2048 by 1536 pixels. Retinal fundus photograph — 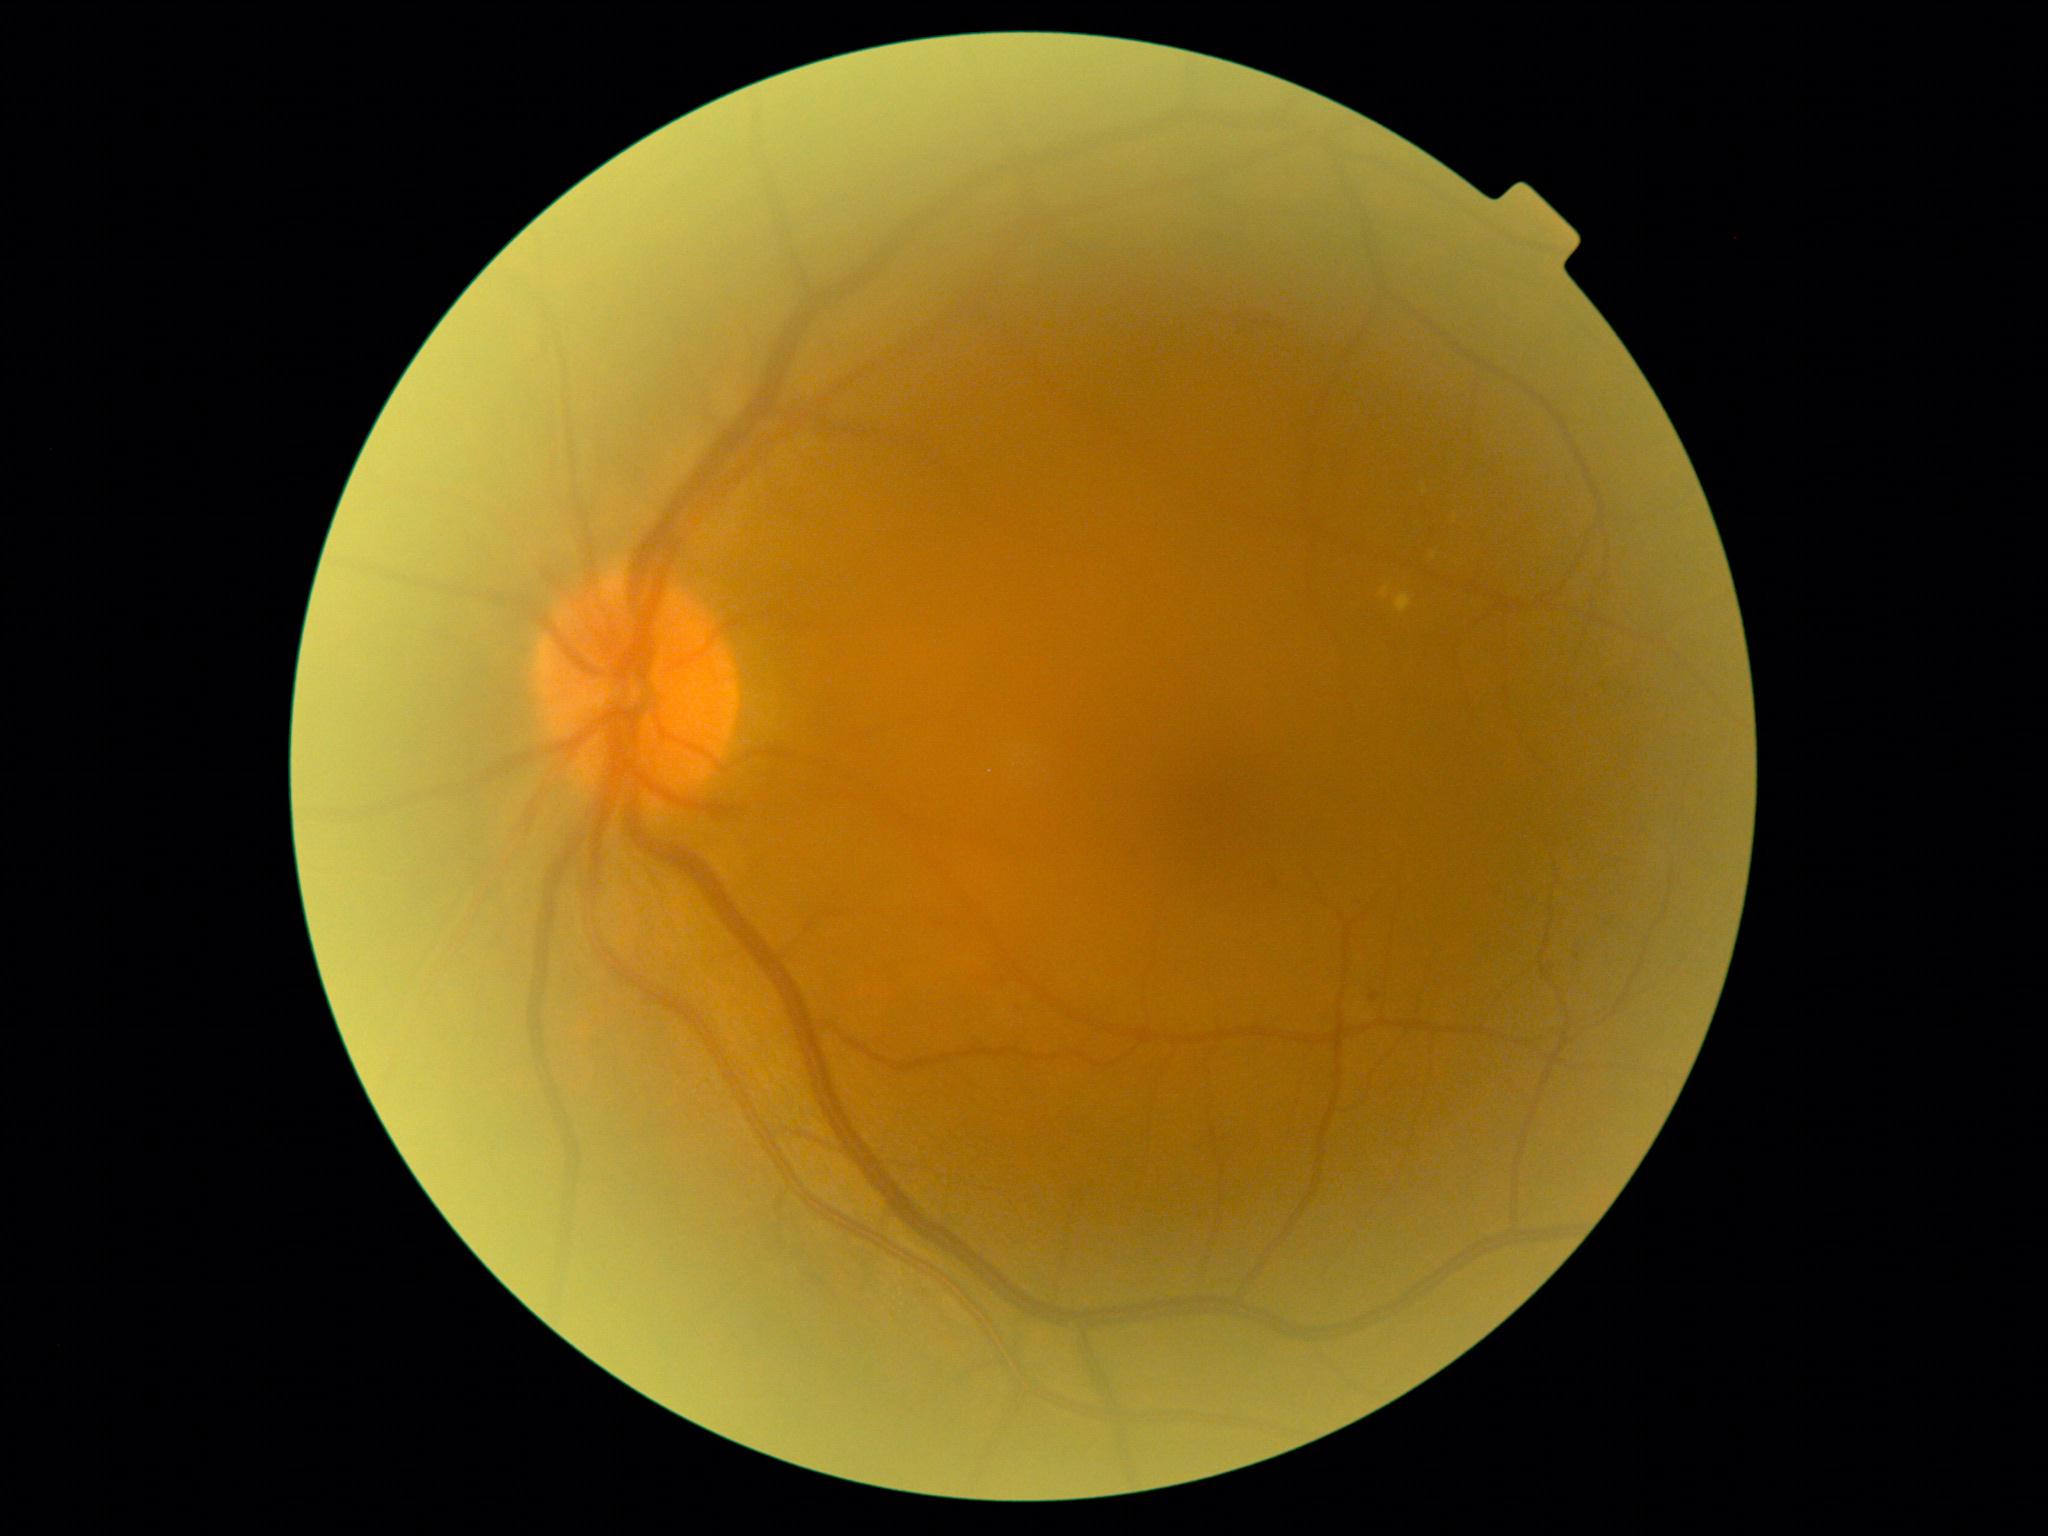 DR stage: 2/4.